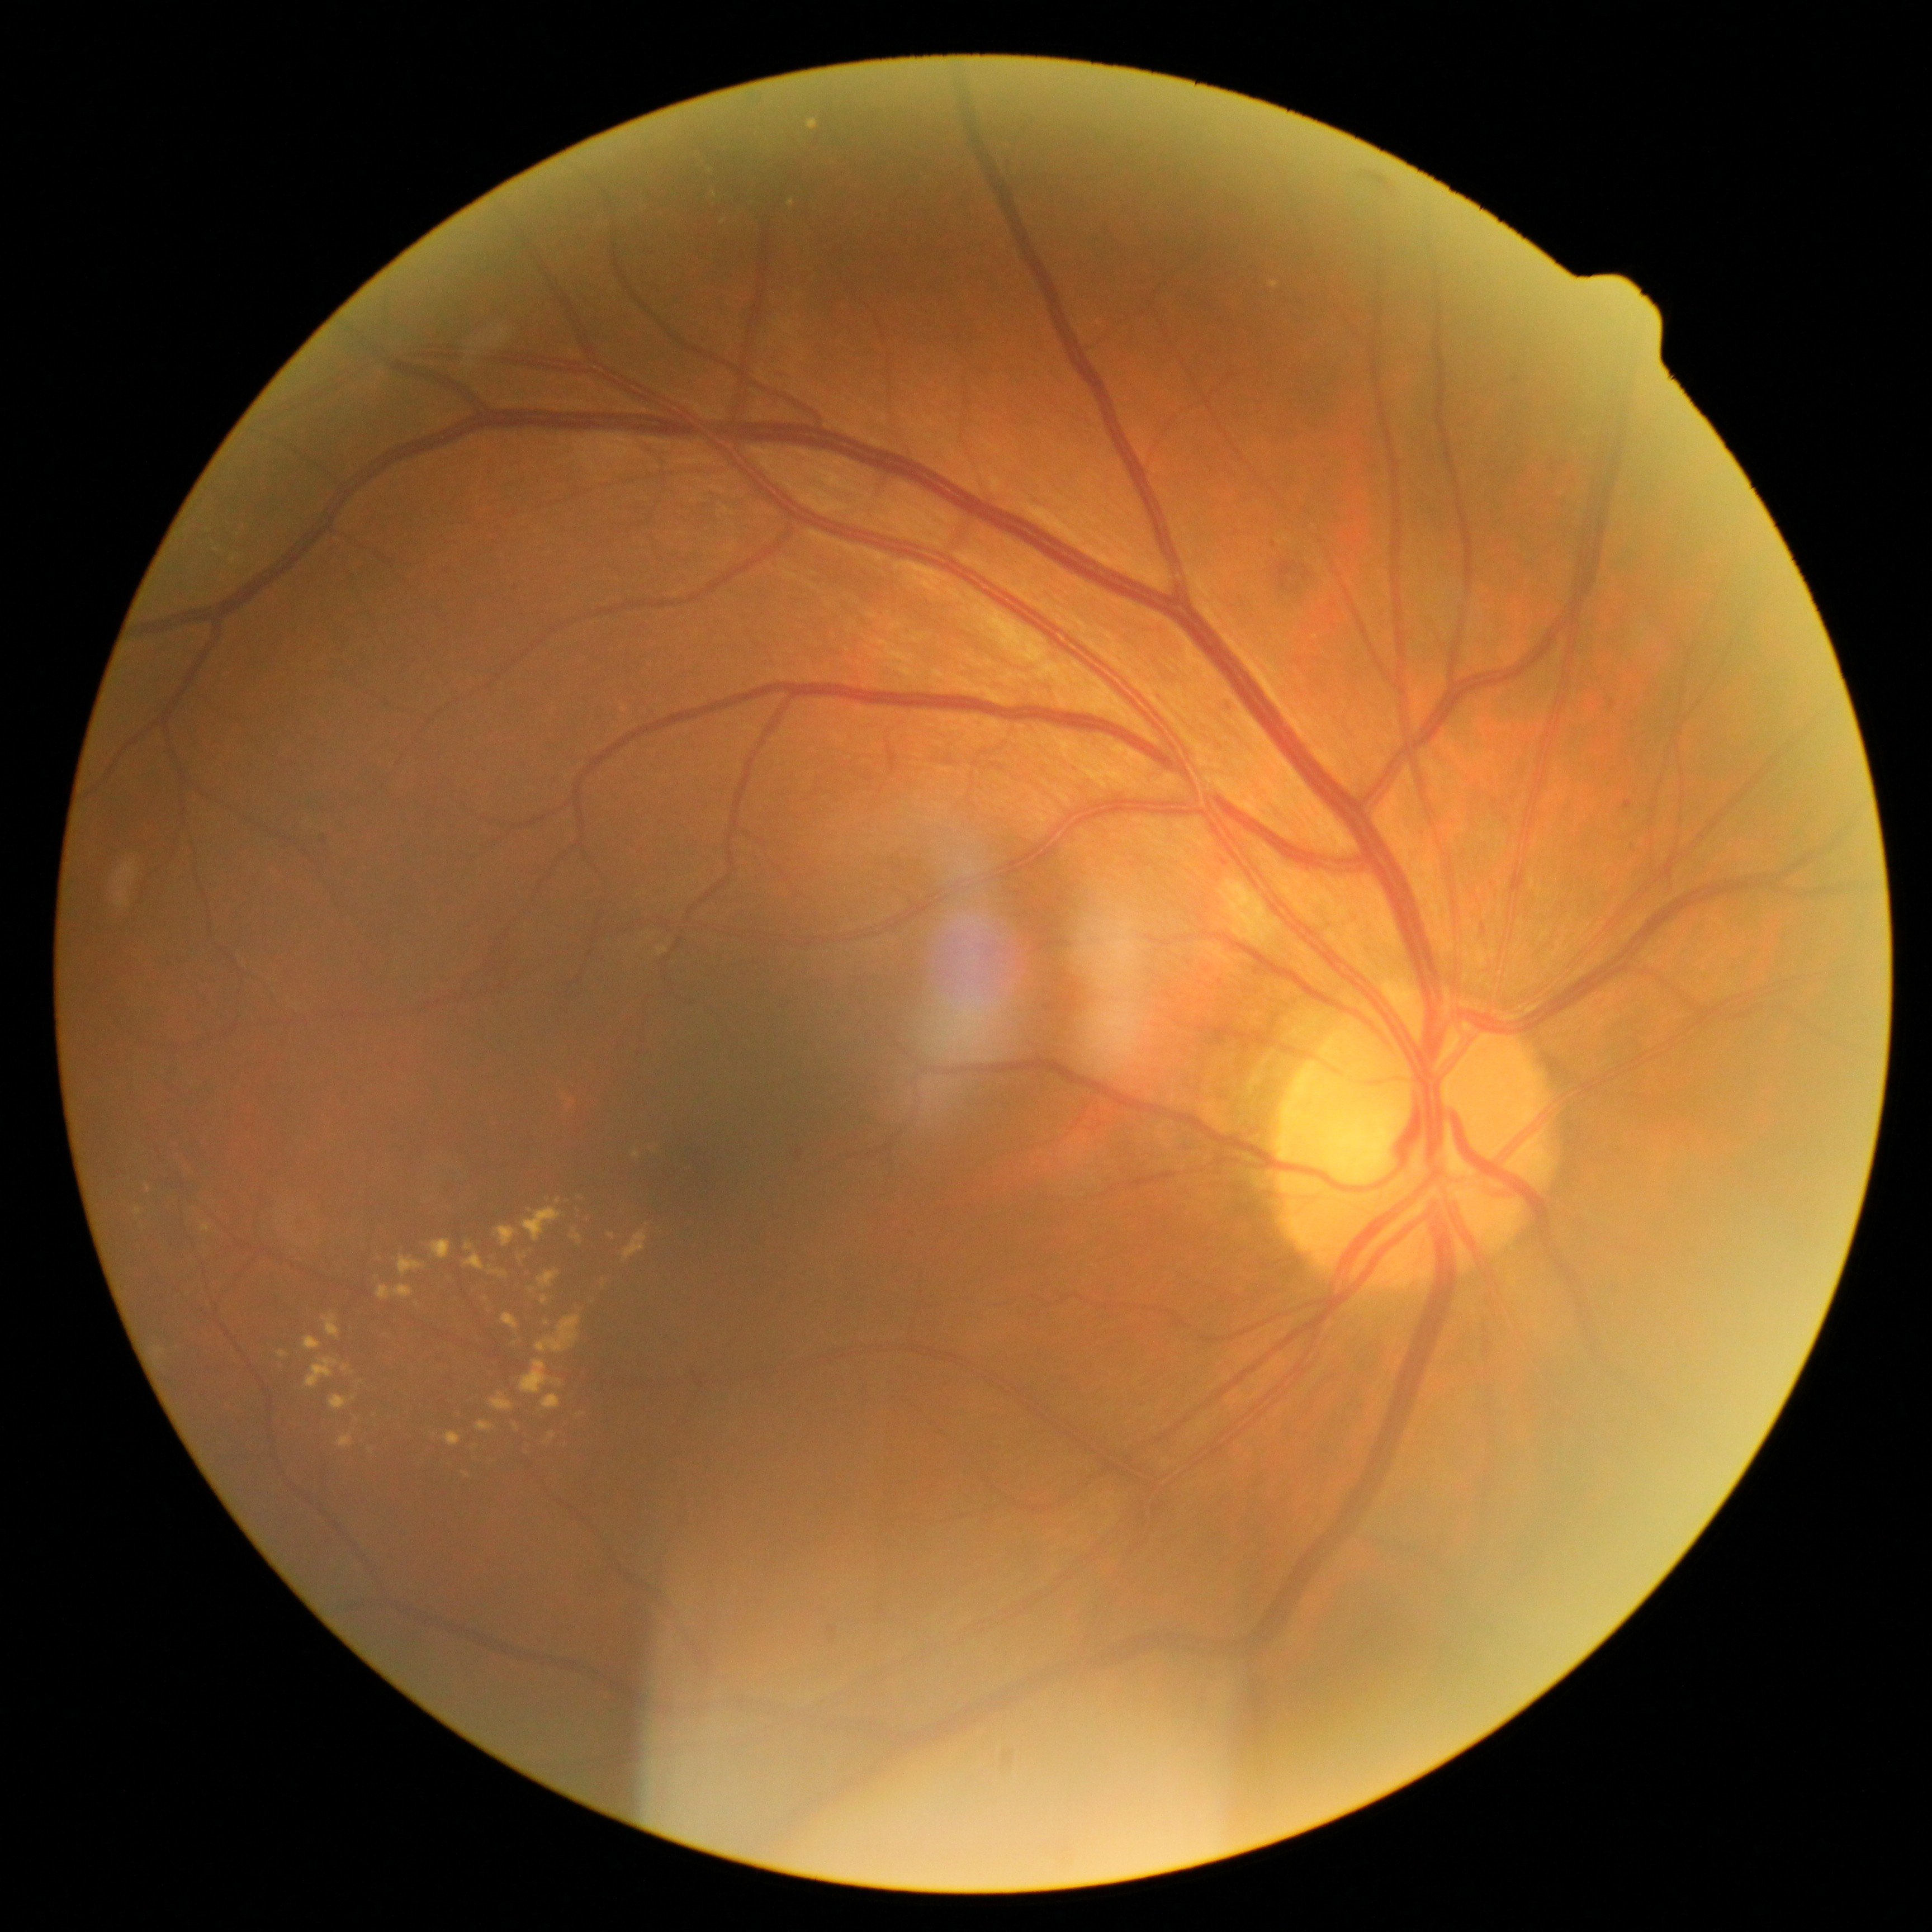

retinopathy=grade 2.